640x480; RetCam wide-field infant fundus image:
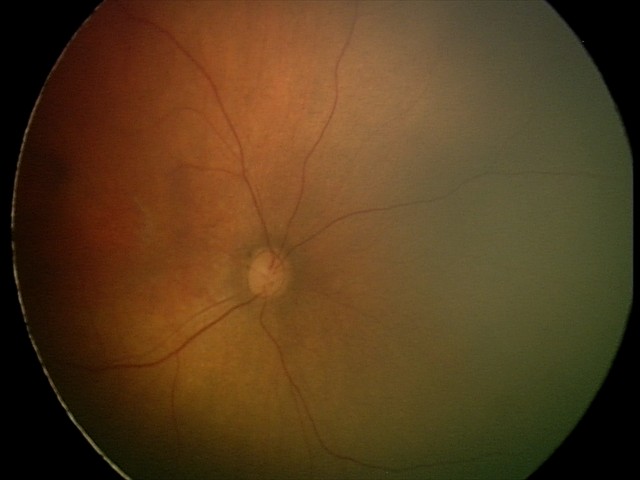
Screening examination diagnosed as physiological.